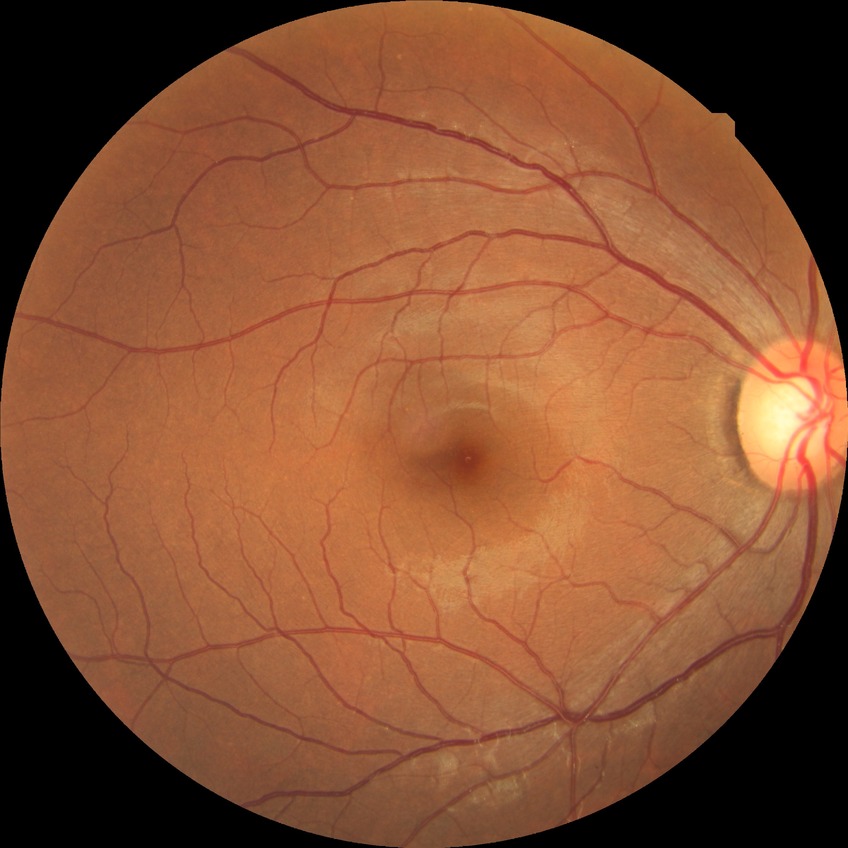

Diabetic retinopathy (DR) is no diabetic retinopathy (NDR).